CFP: 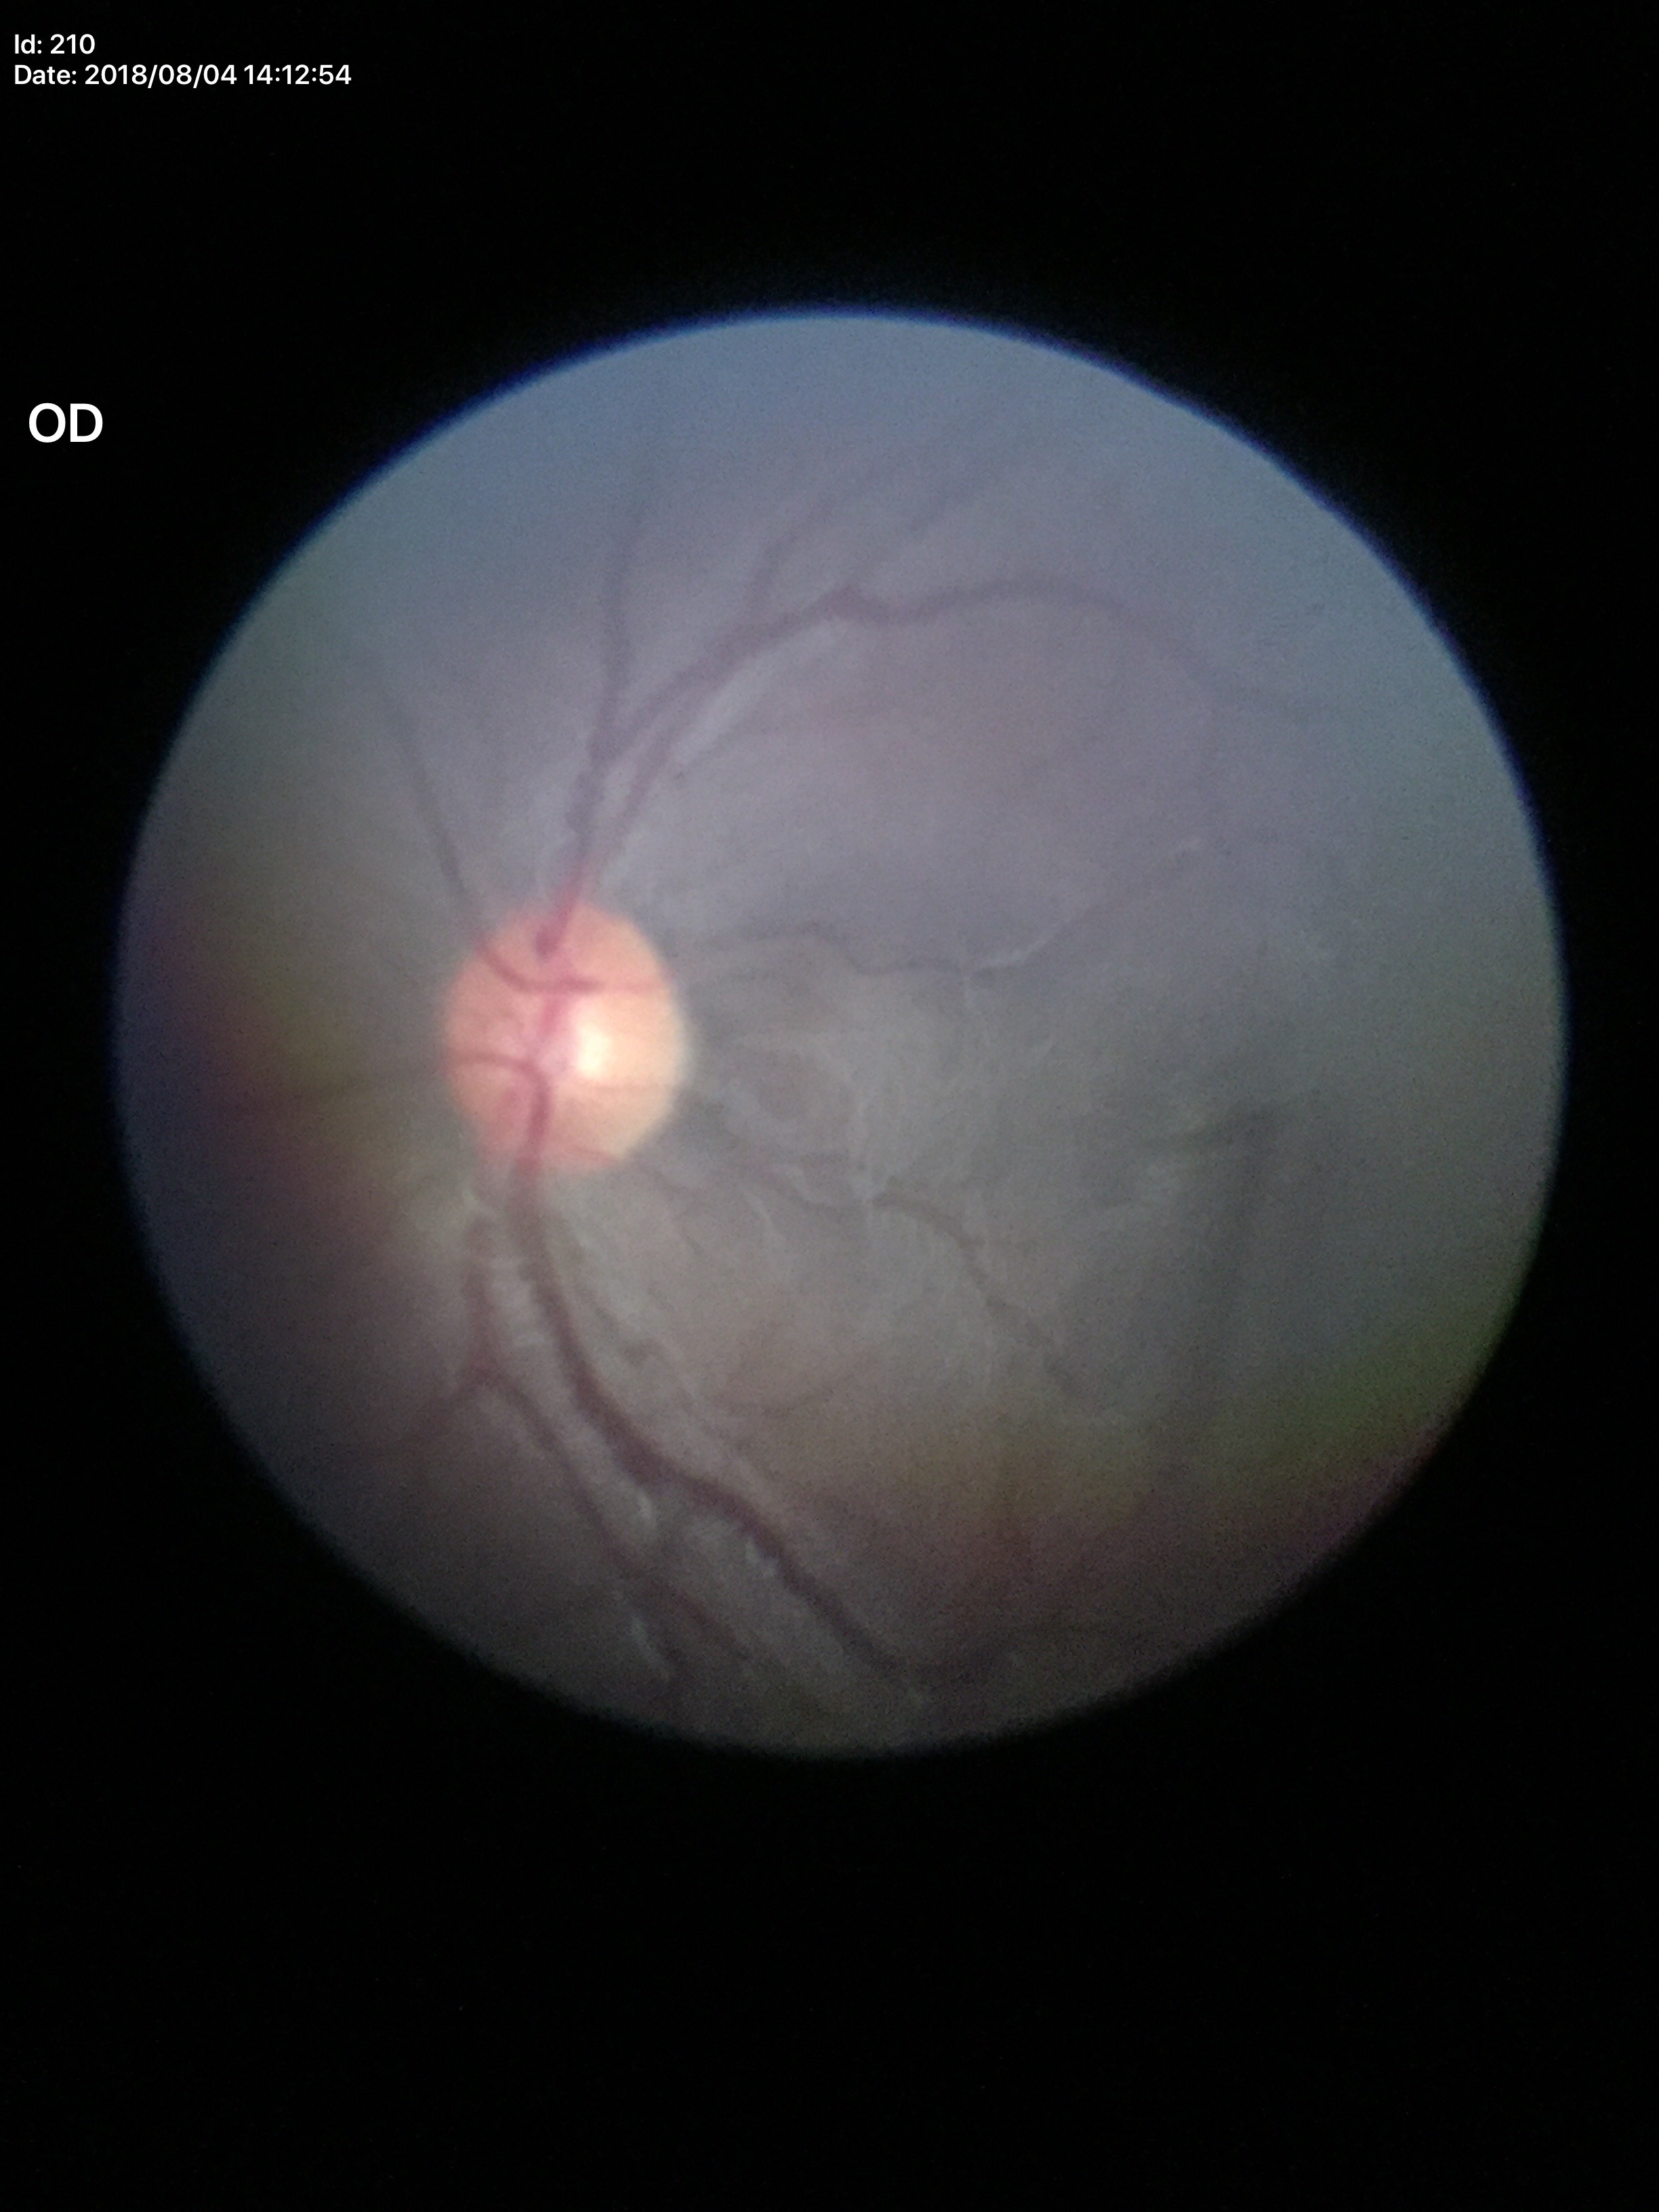

vertical C/D ratio (VCDR): 0.50; Glaucoma screening impression: no suspicious findings.